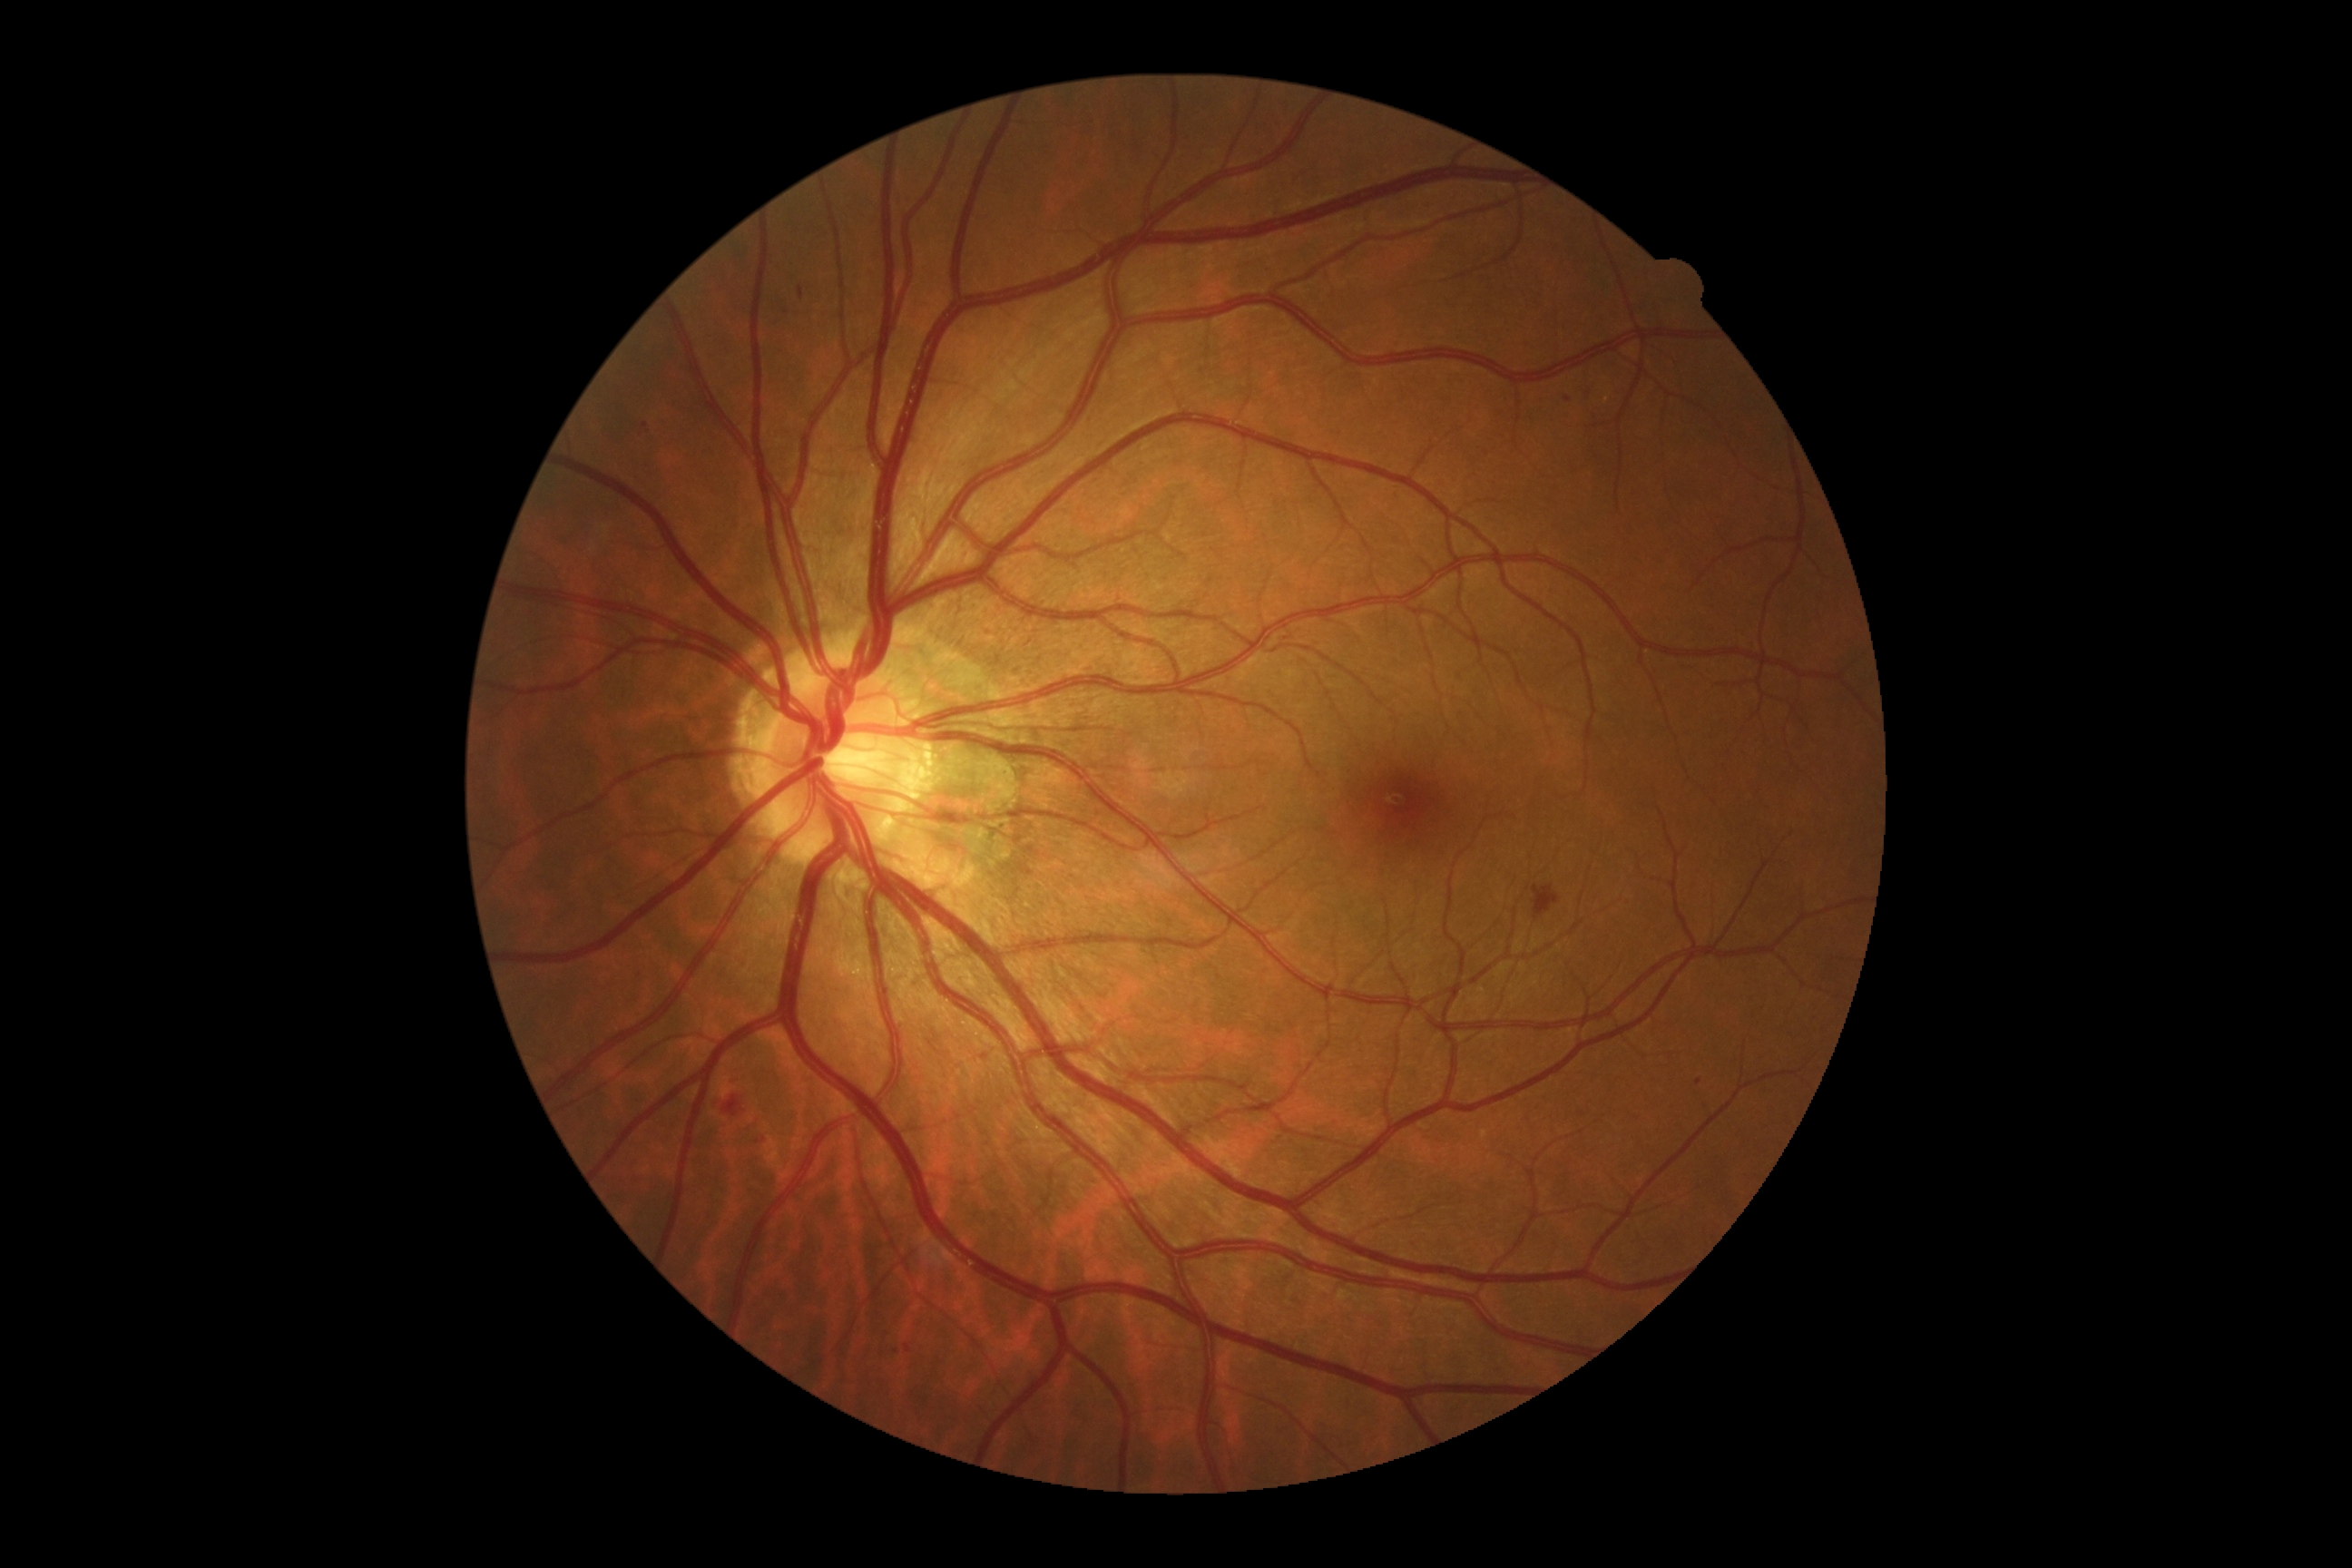

DR severity: moderate non-proliferative diabetic retinopathy (grade 2) — more than just microaneurysms but less than severe NPDR.